848x848, without pupil dilation — 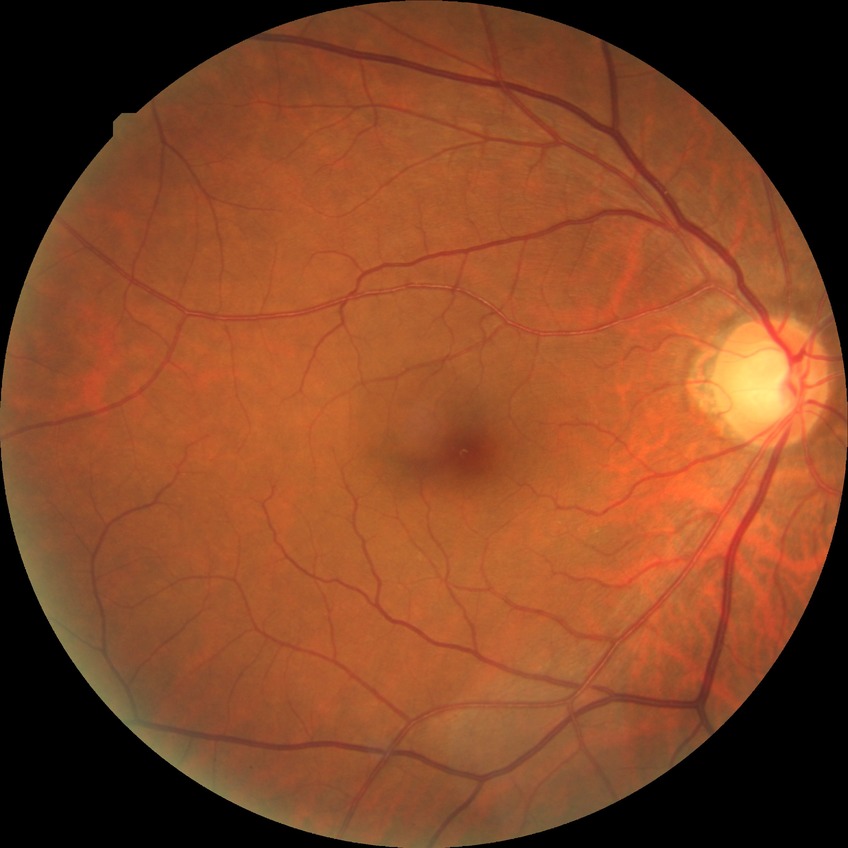
{
  "davis_grade": "NDR (no diabetic retinopathy)"
}